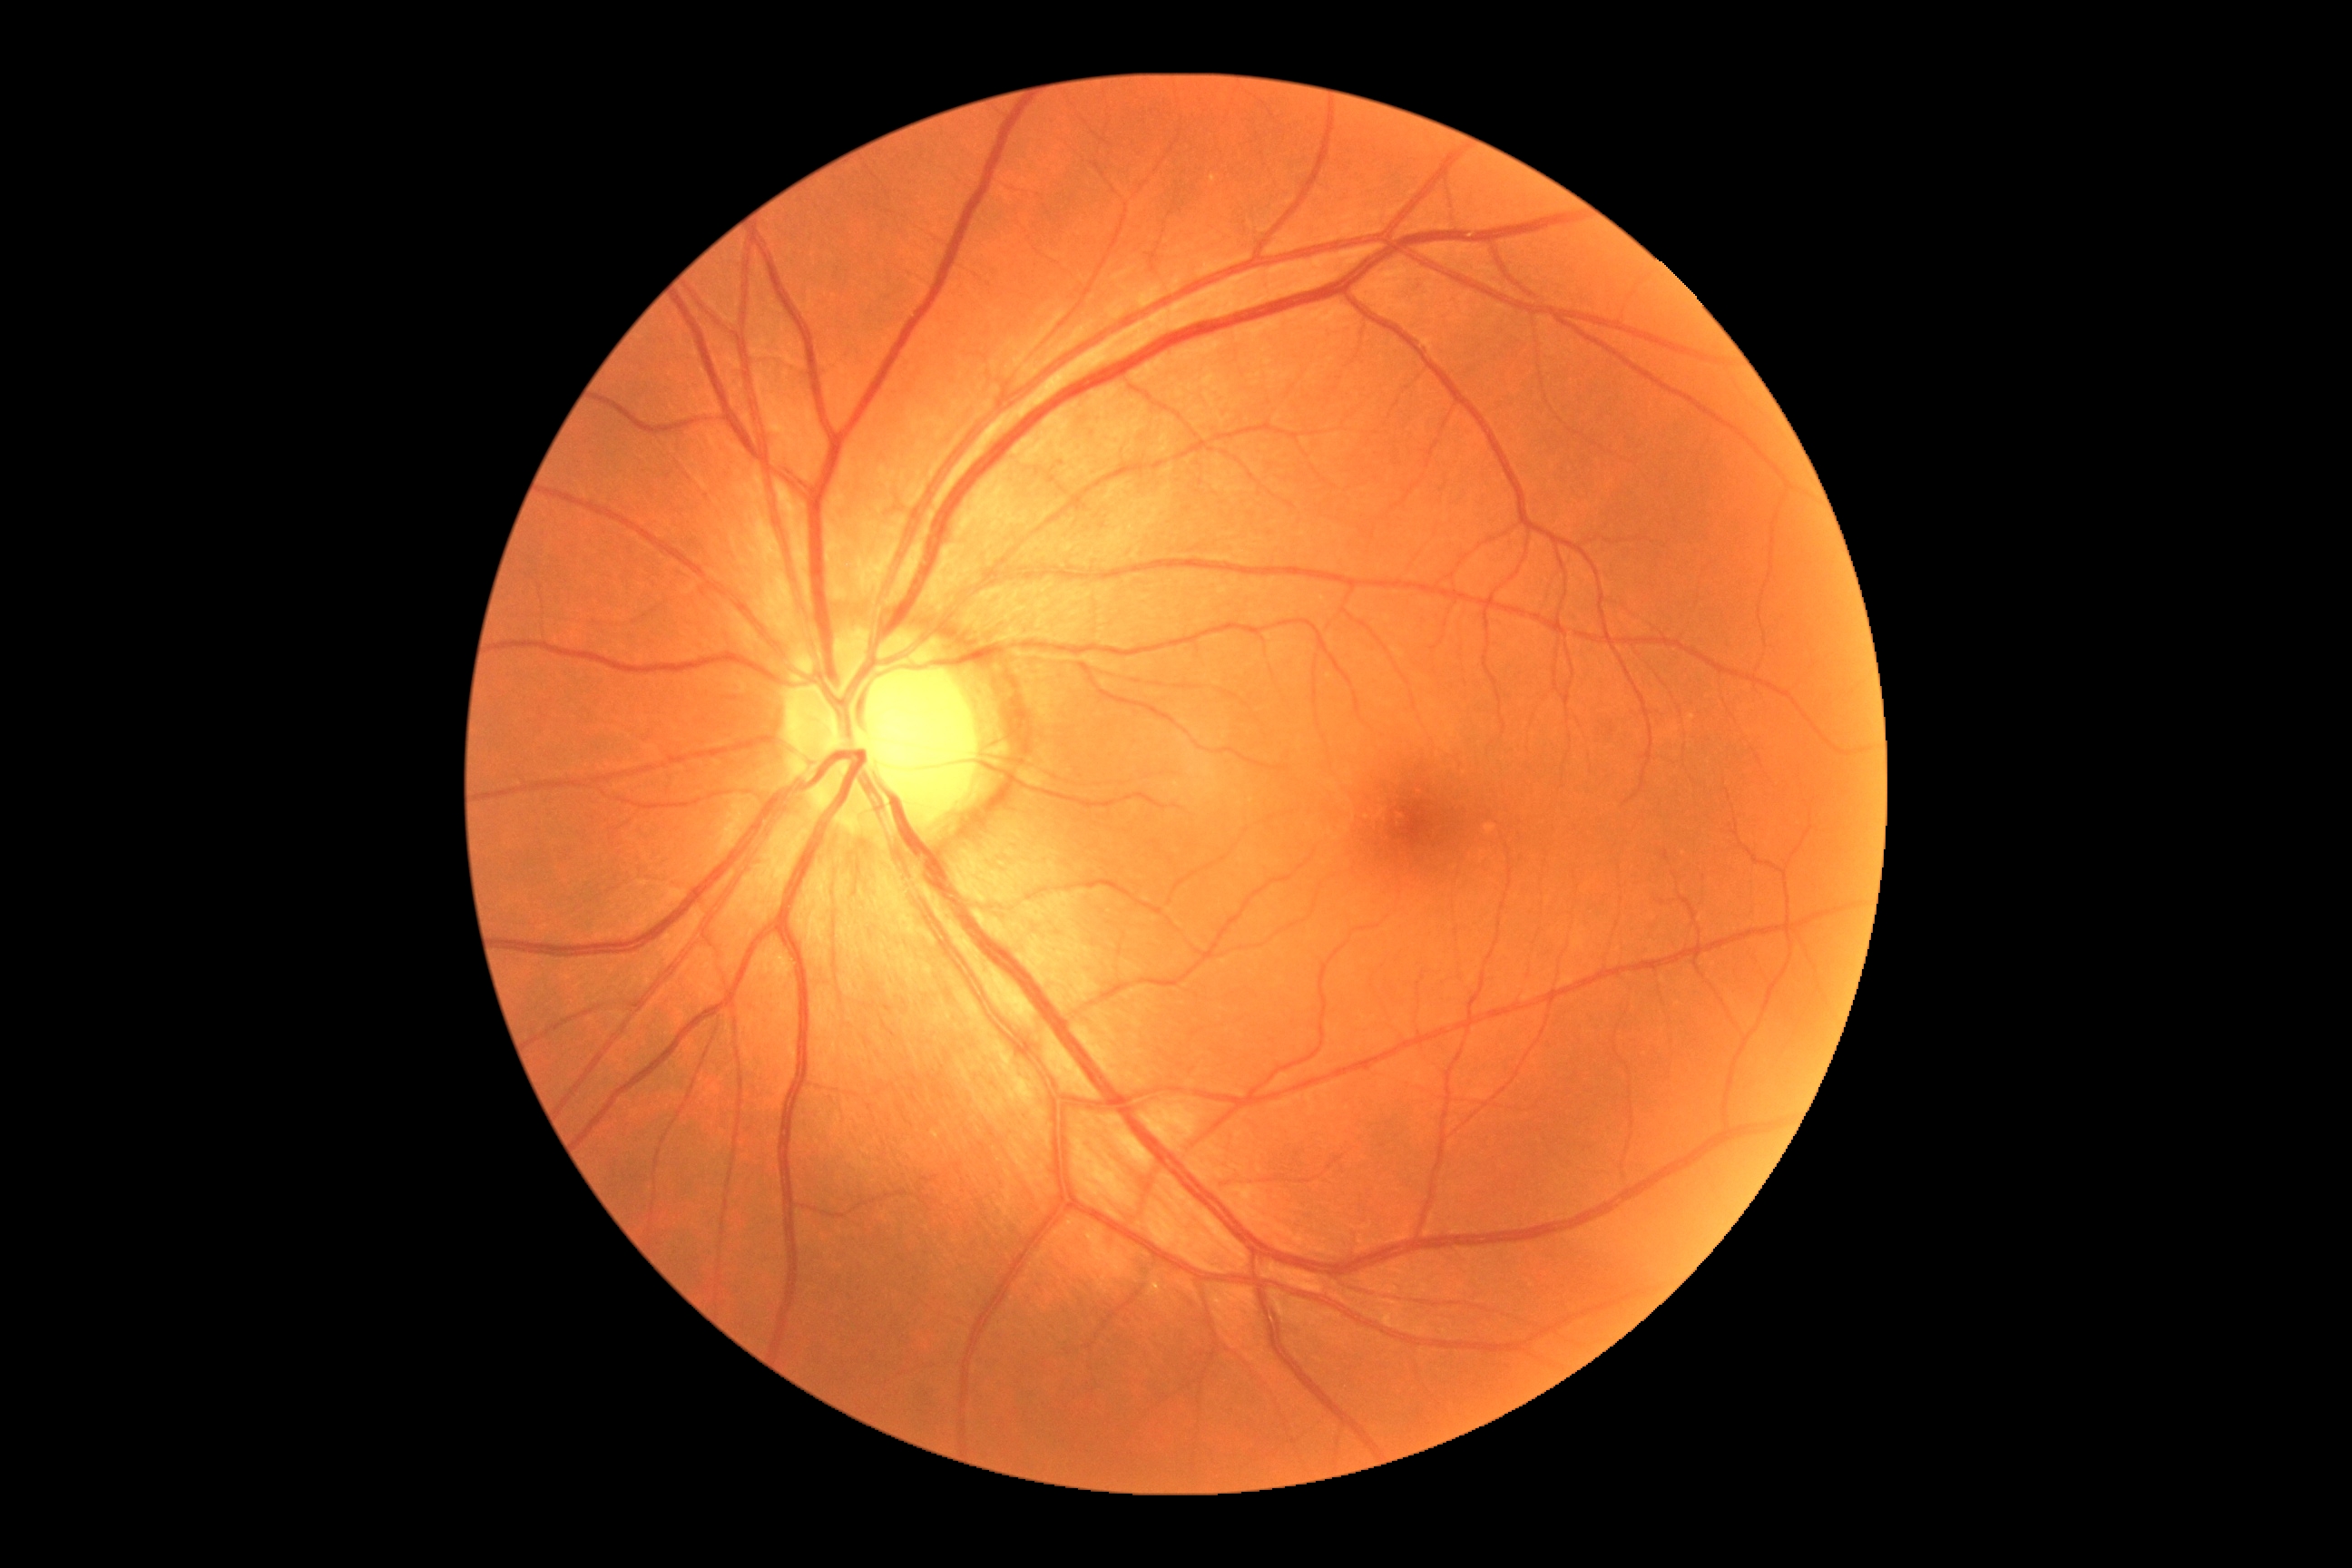

DR impression = negative for DR, DR stage = grade 0 (no apparent retinopathy).